Captured with the Clarity RetCam 3 (130° field of view); wide-field fundus photograph from neonatal ROP screening: 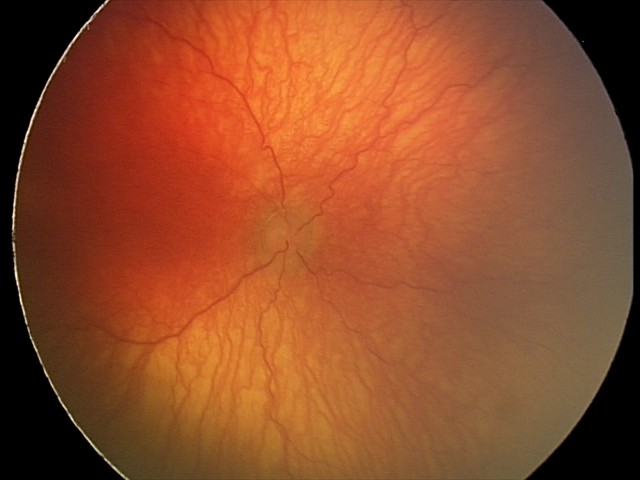 Screening: aggressive retinopathy of prematurity; plus disease — abnormal dilation and tortuosity of the posterior pole retinal vessels.